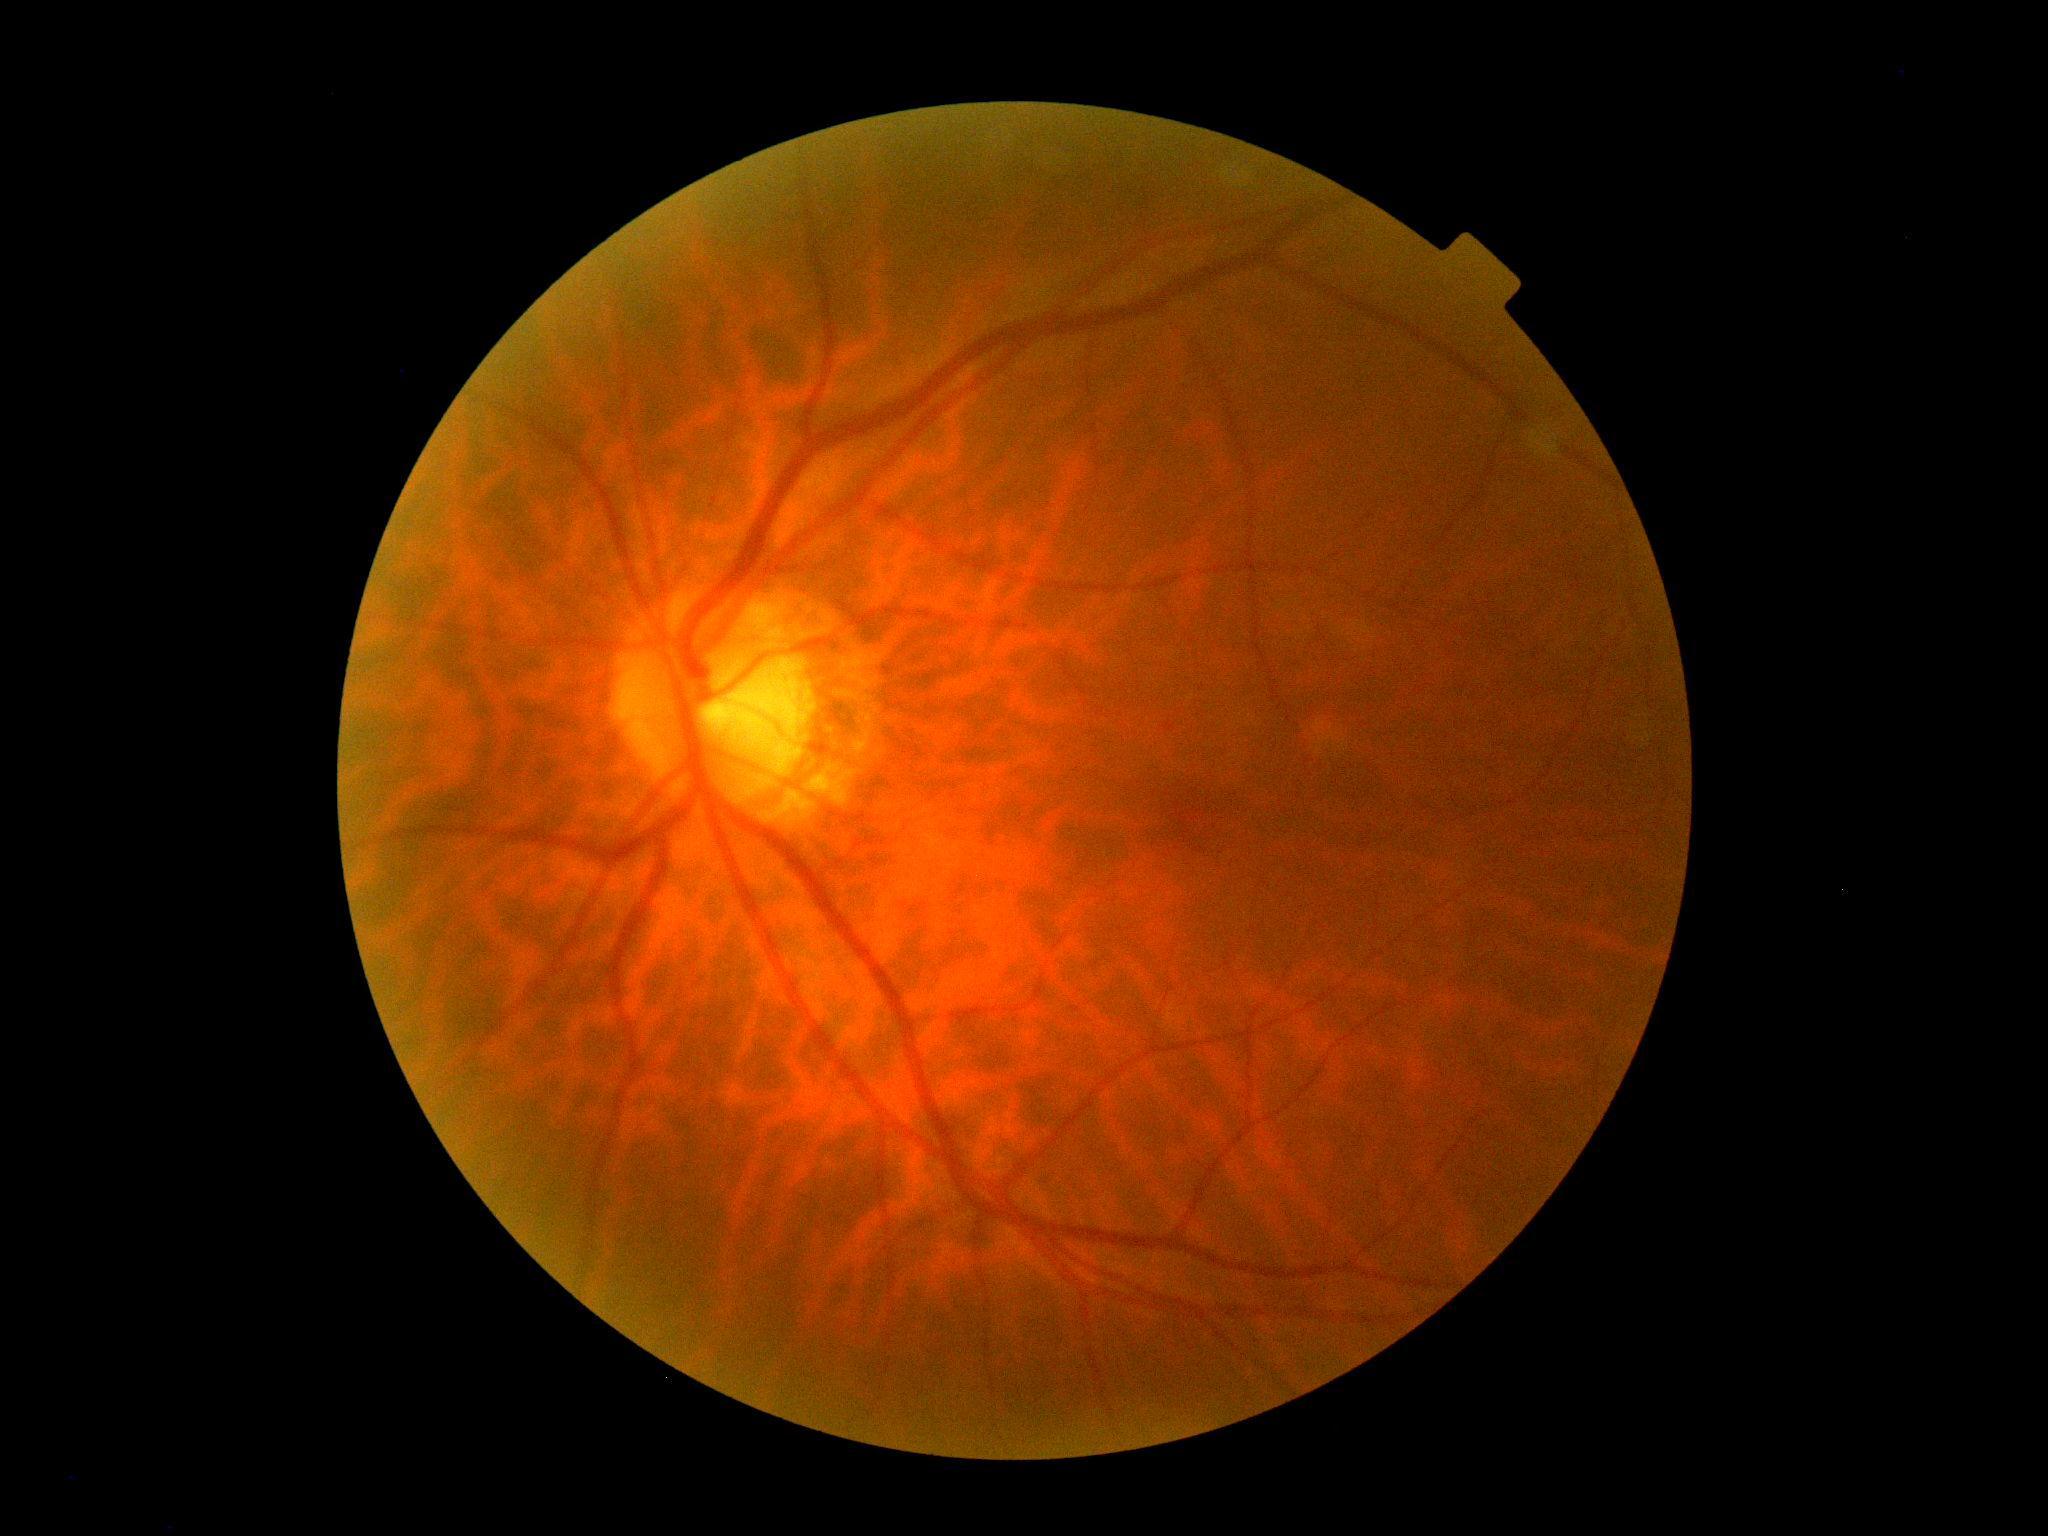

Annotations:
- diabetic retinopathy (DR): grade 0 (no apparent retinopathy) — no visible signs of diabetic retinopathy
- DR impression: no apparent DR